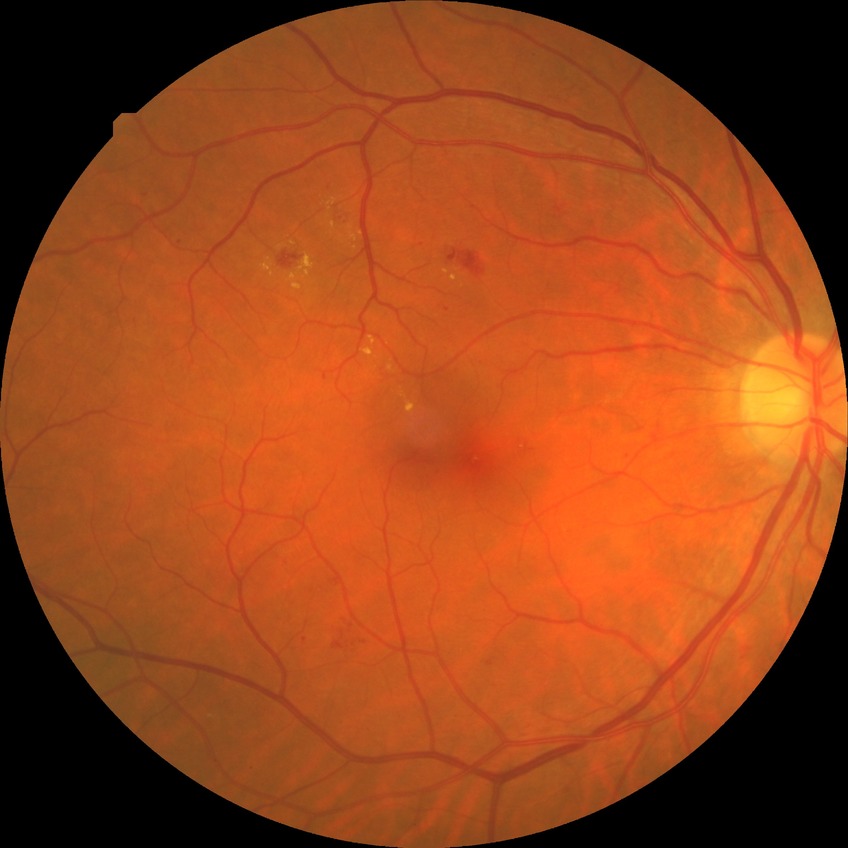
Davis grade = SDR.